Retinal fundus photograph, 2212x1659: 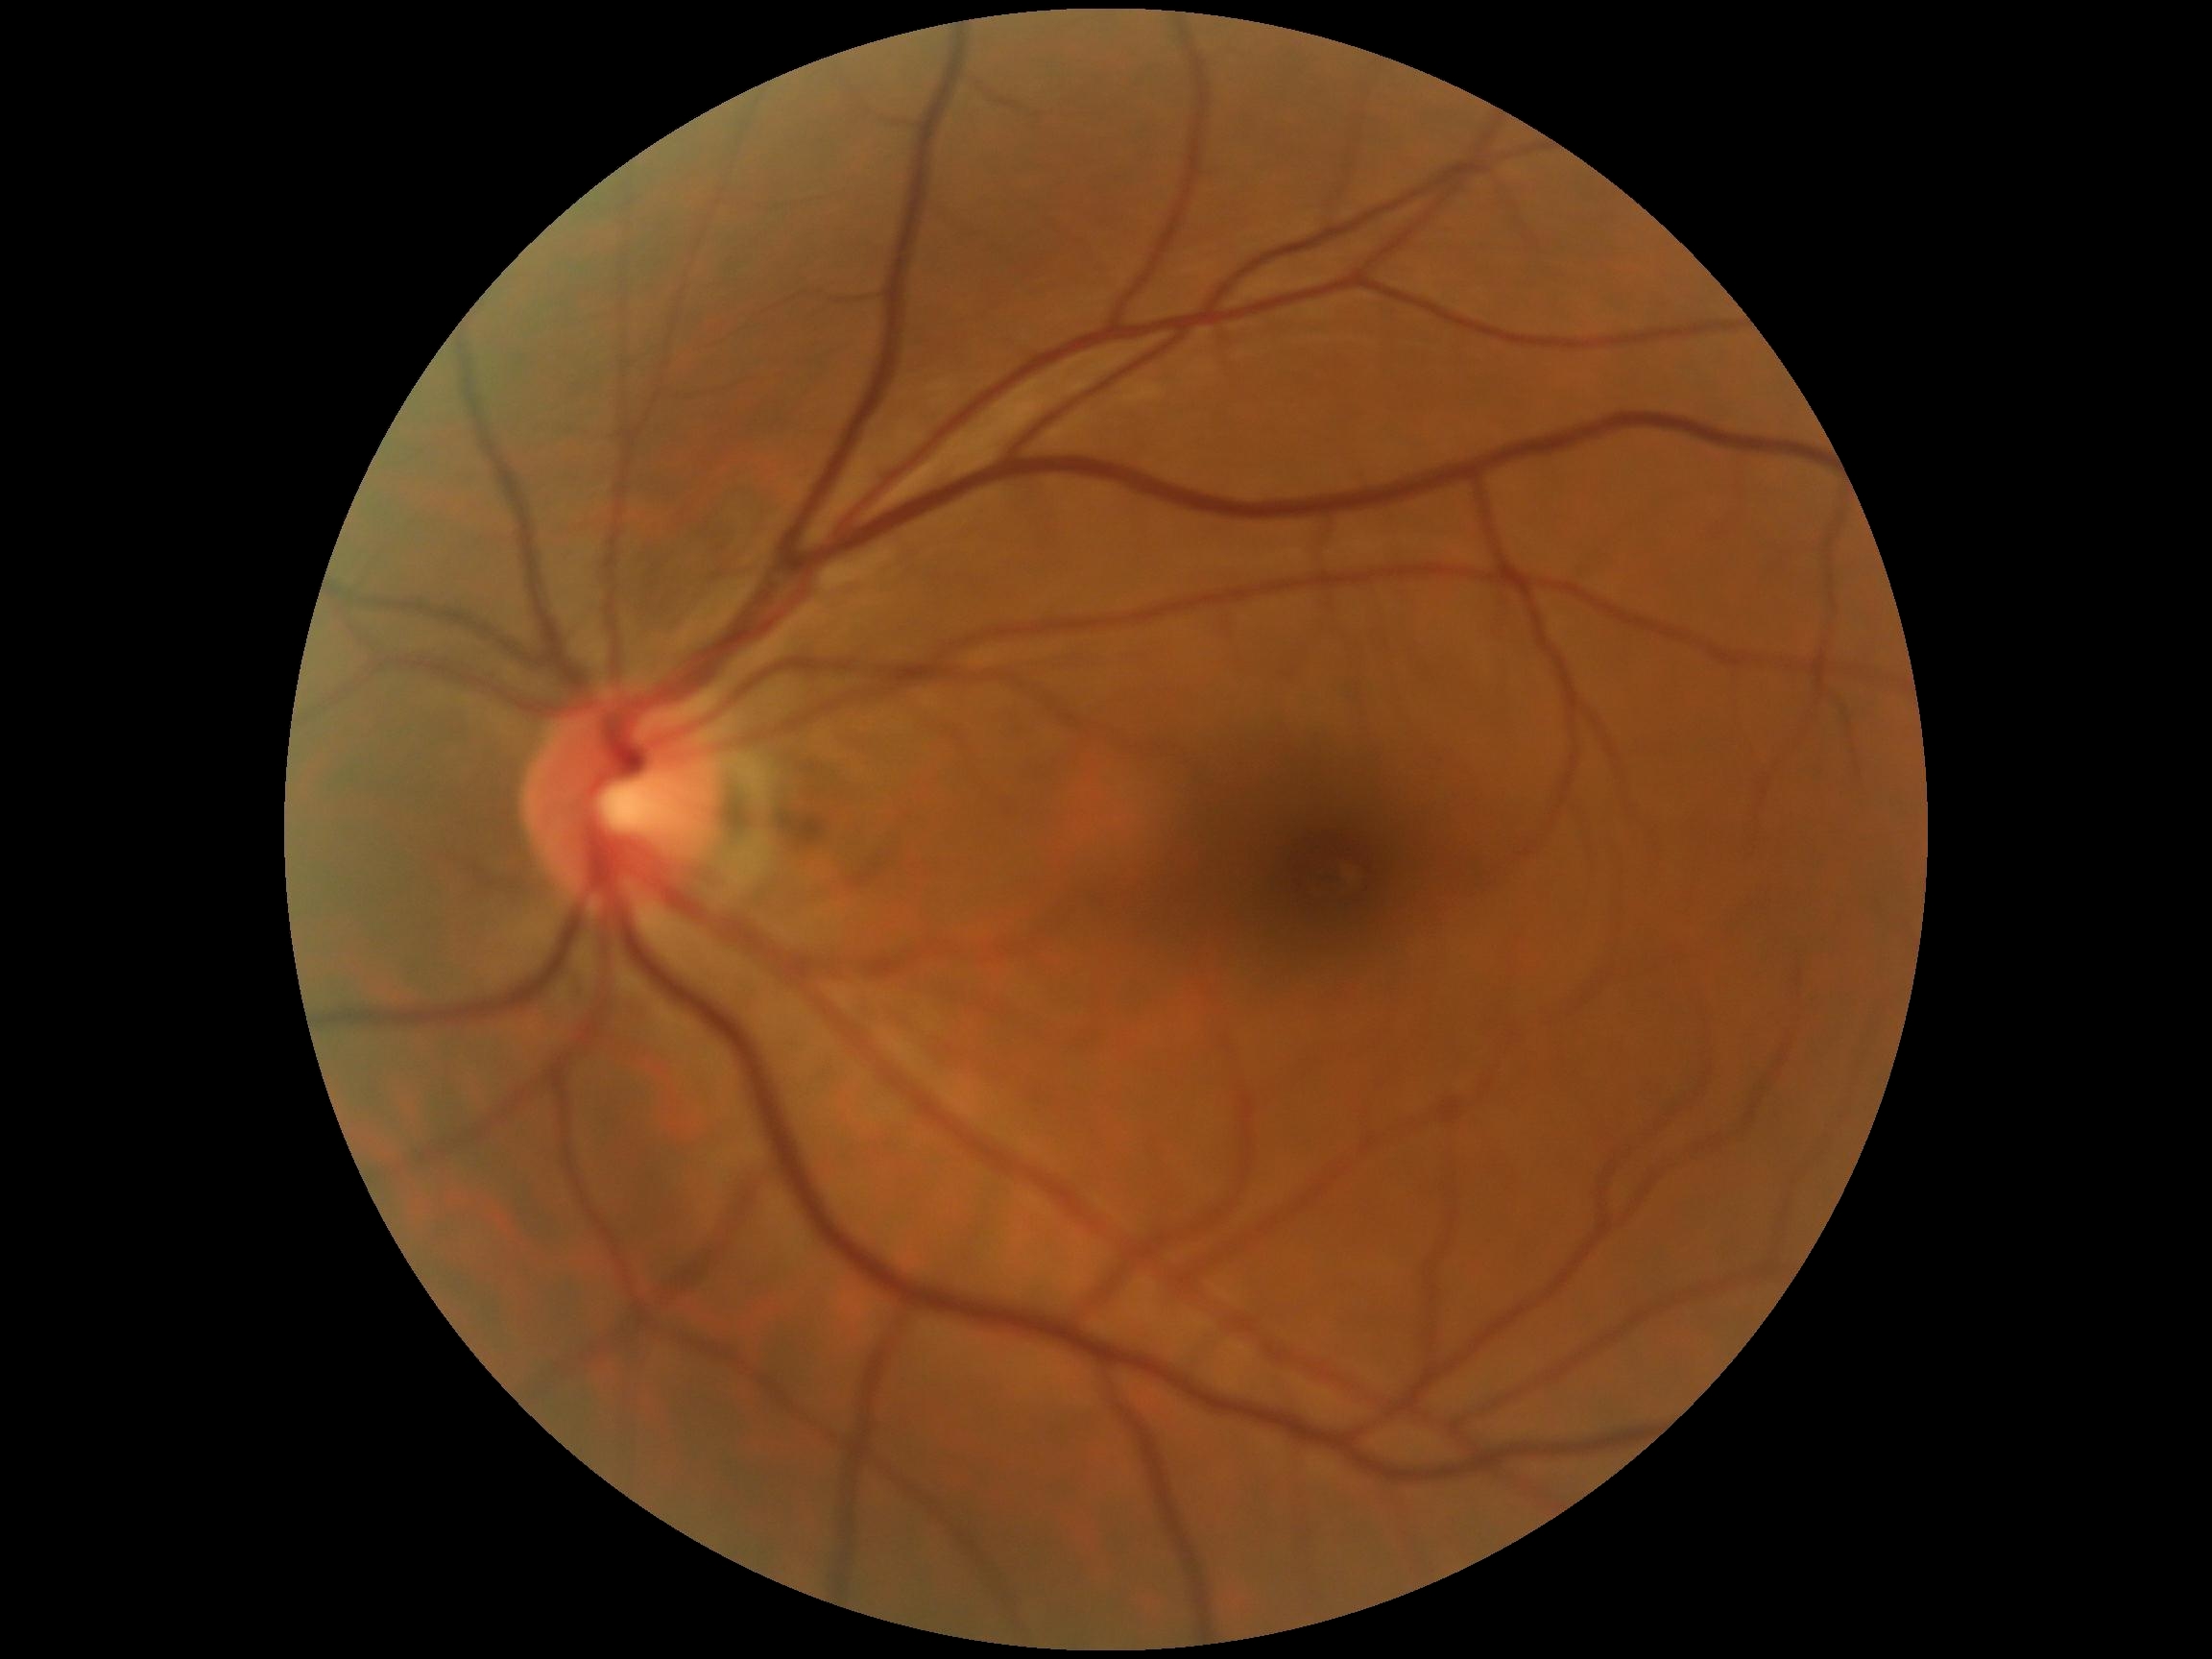
DR grade = 0 (no apparent retinopathy).